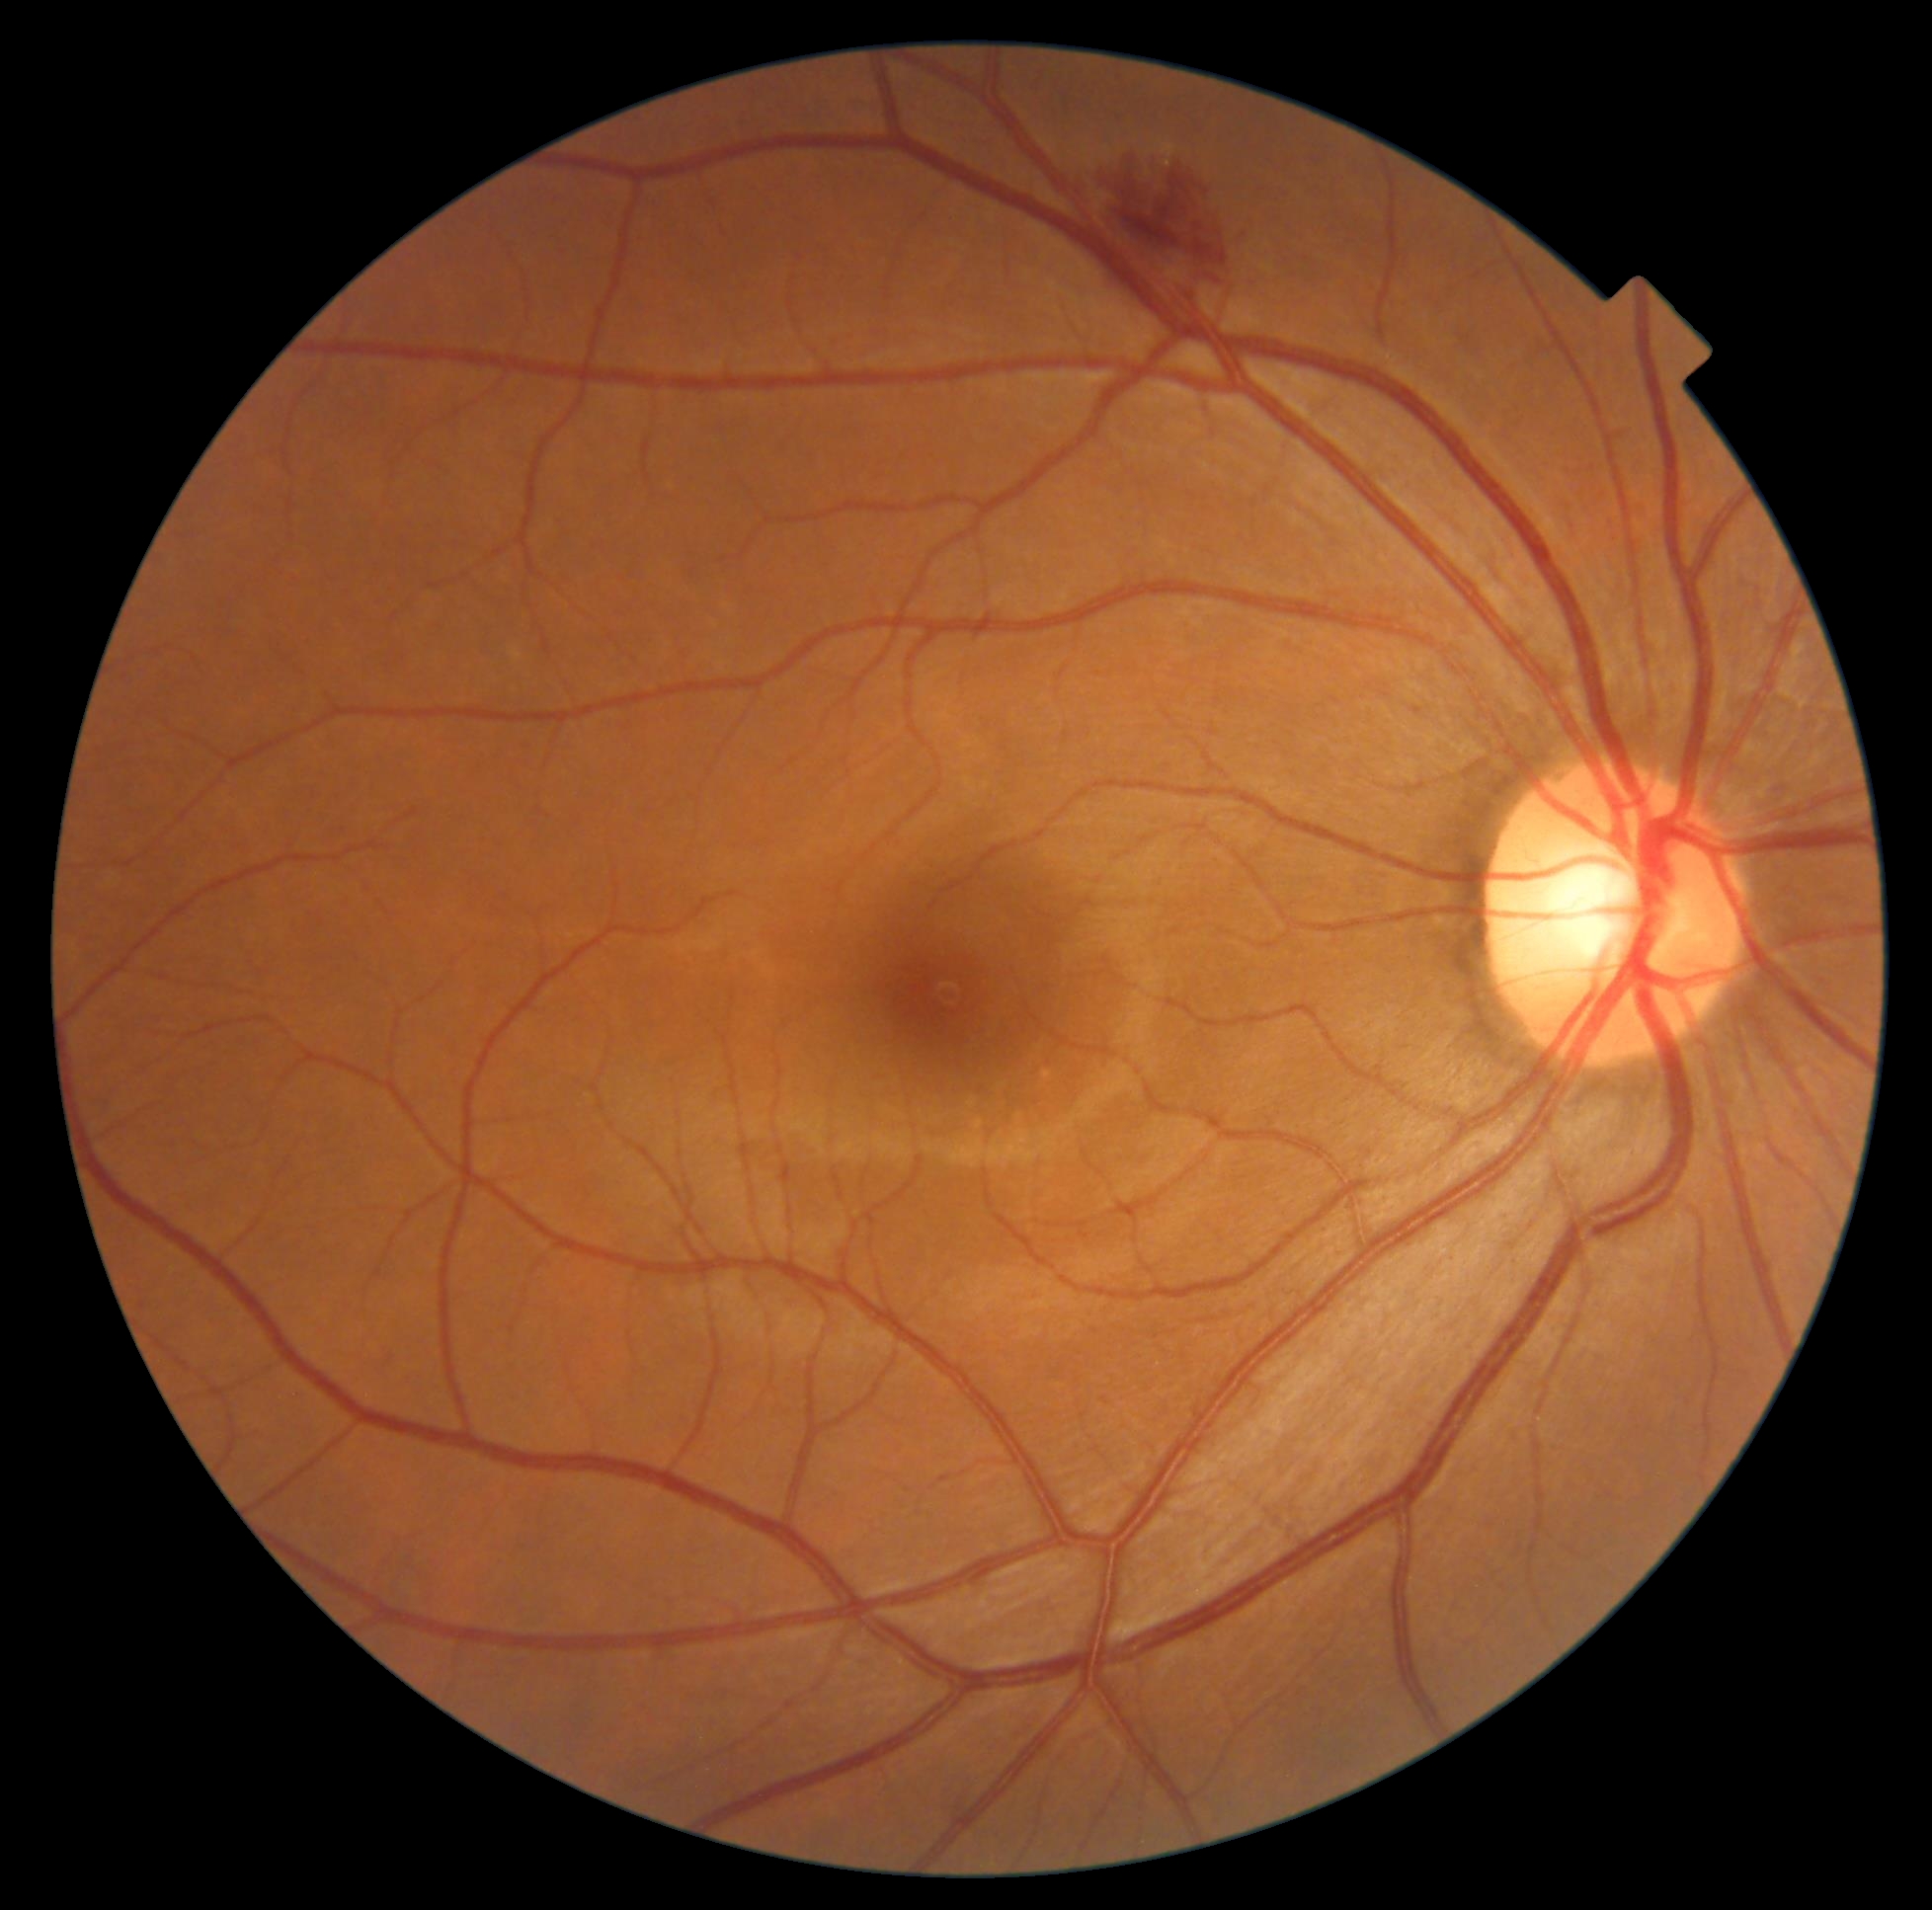 diabetic retinopathy=grade 2 (moderate NPDR).